Acquired on the Clarity RetCam 3 · image size 640x480 · wide-field fundus image from infant ROP screening.
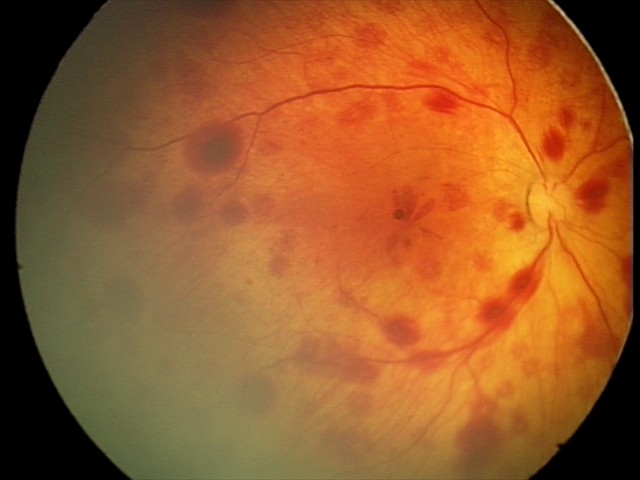
Screening series with retinal hemorrhages.